240x240px:
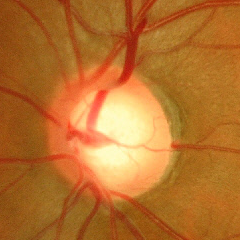
Q: What stage of glaucoma is present?
A: Advanced glaucomatous optic neuropathy.